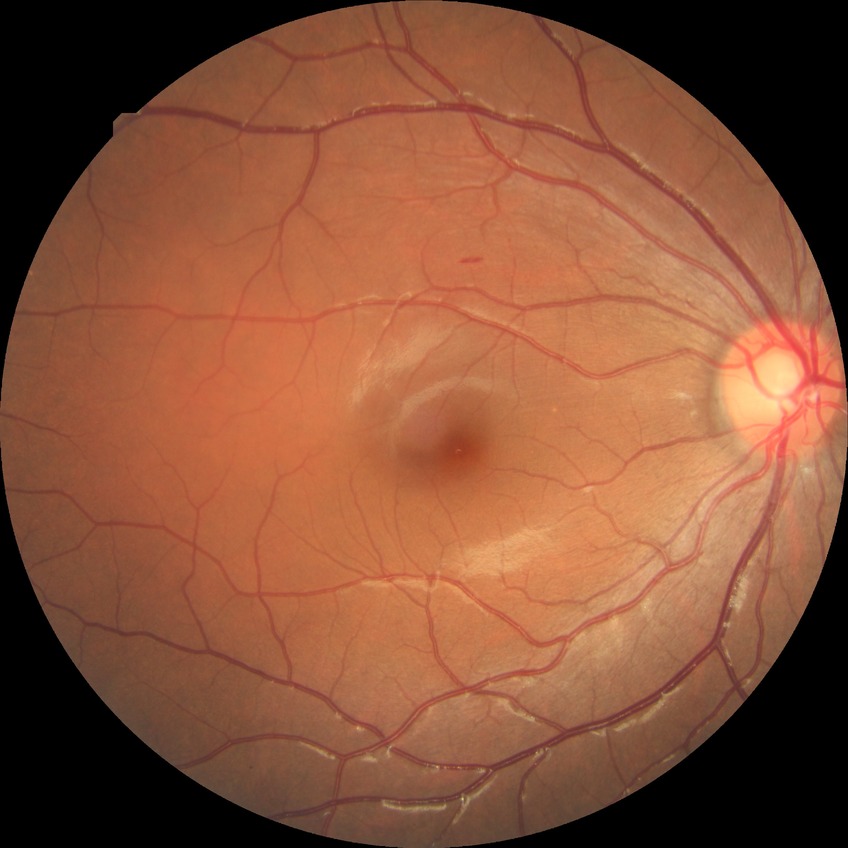
Diabetic retinopathy (DR): no diabetic retinopathy (NDR).